Image size 2352x1568:
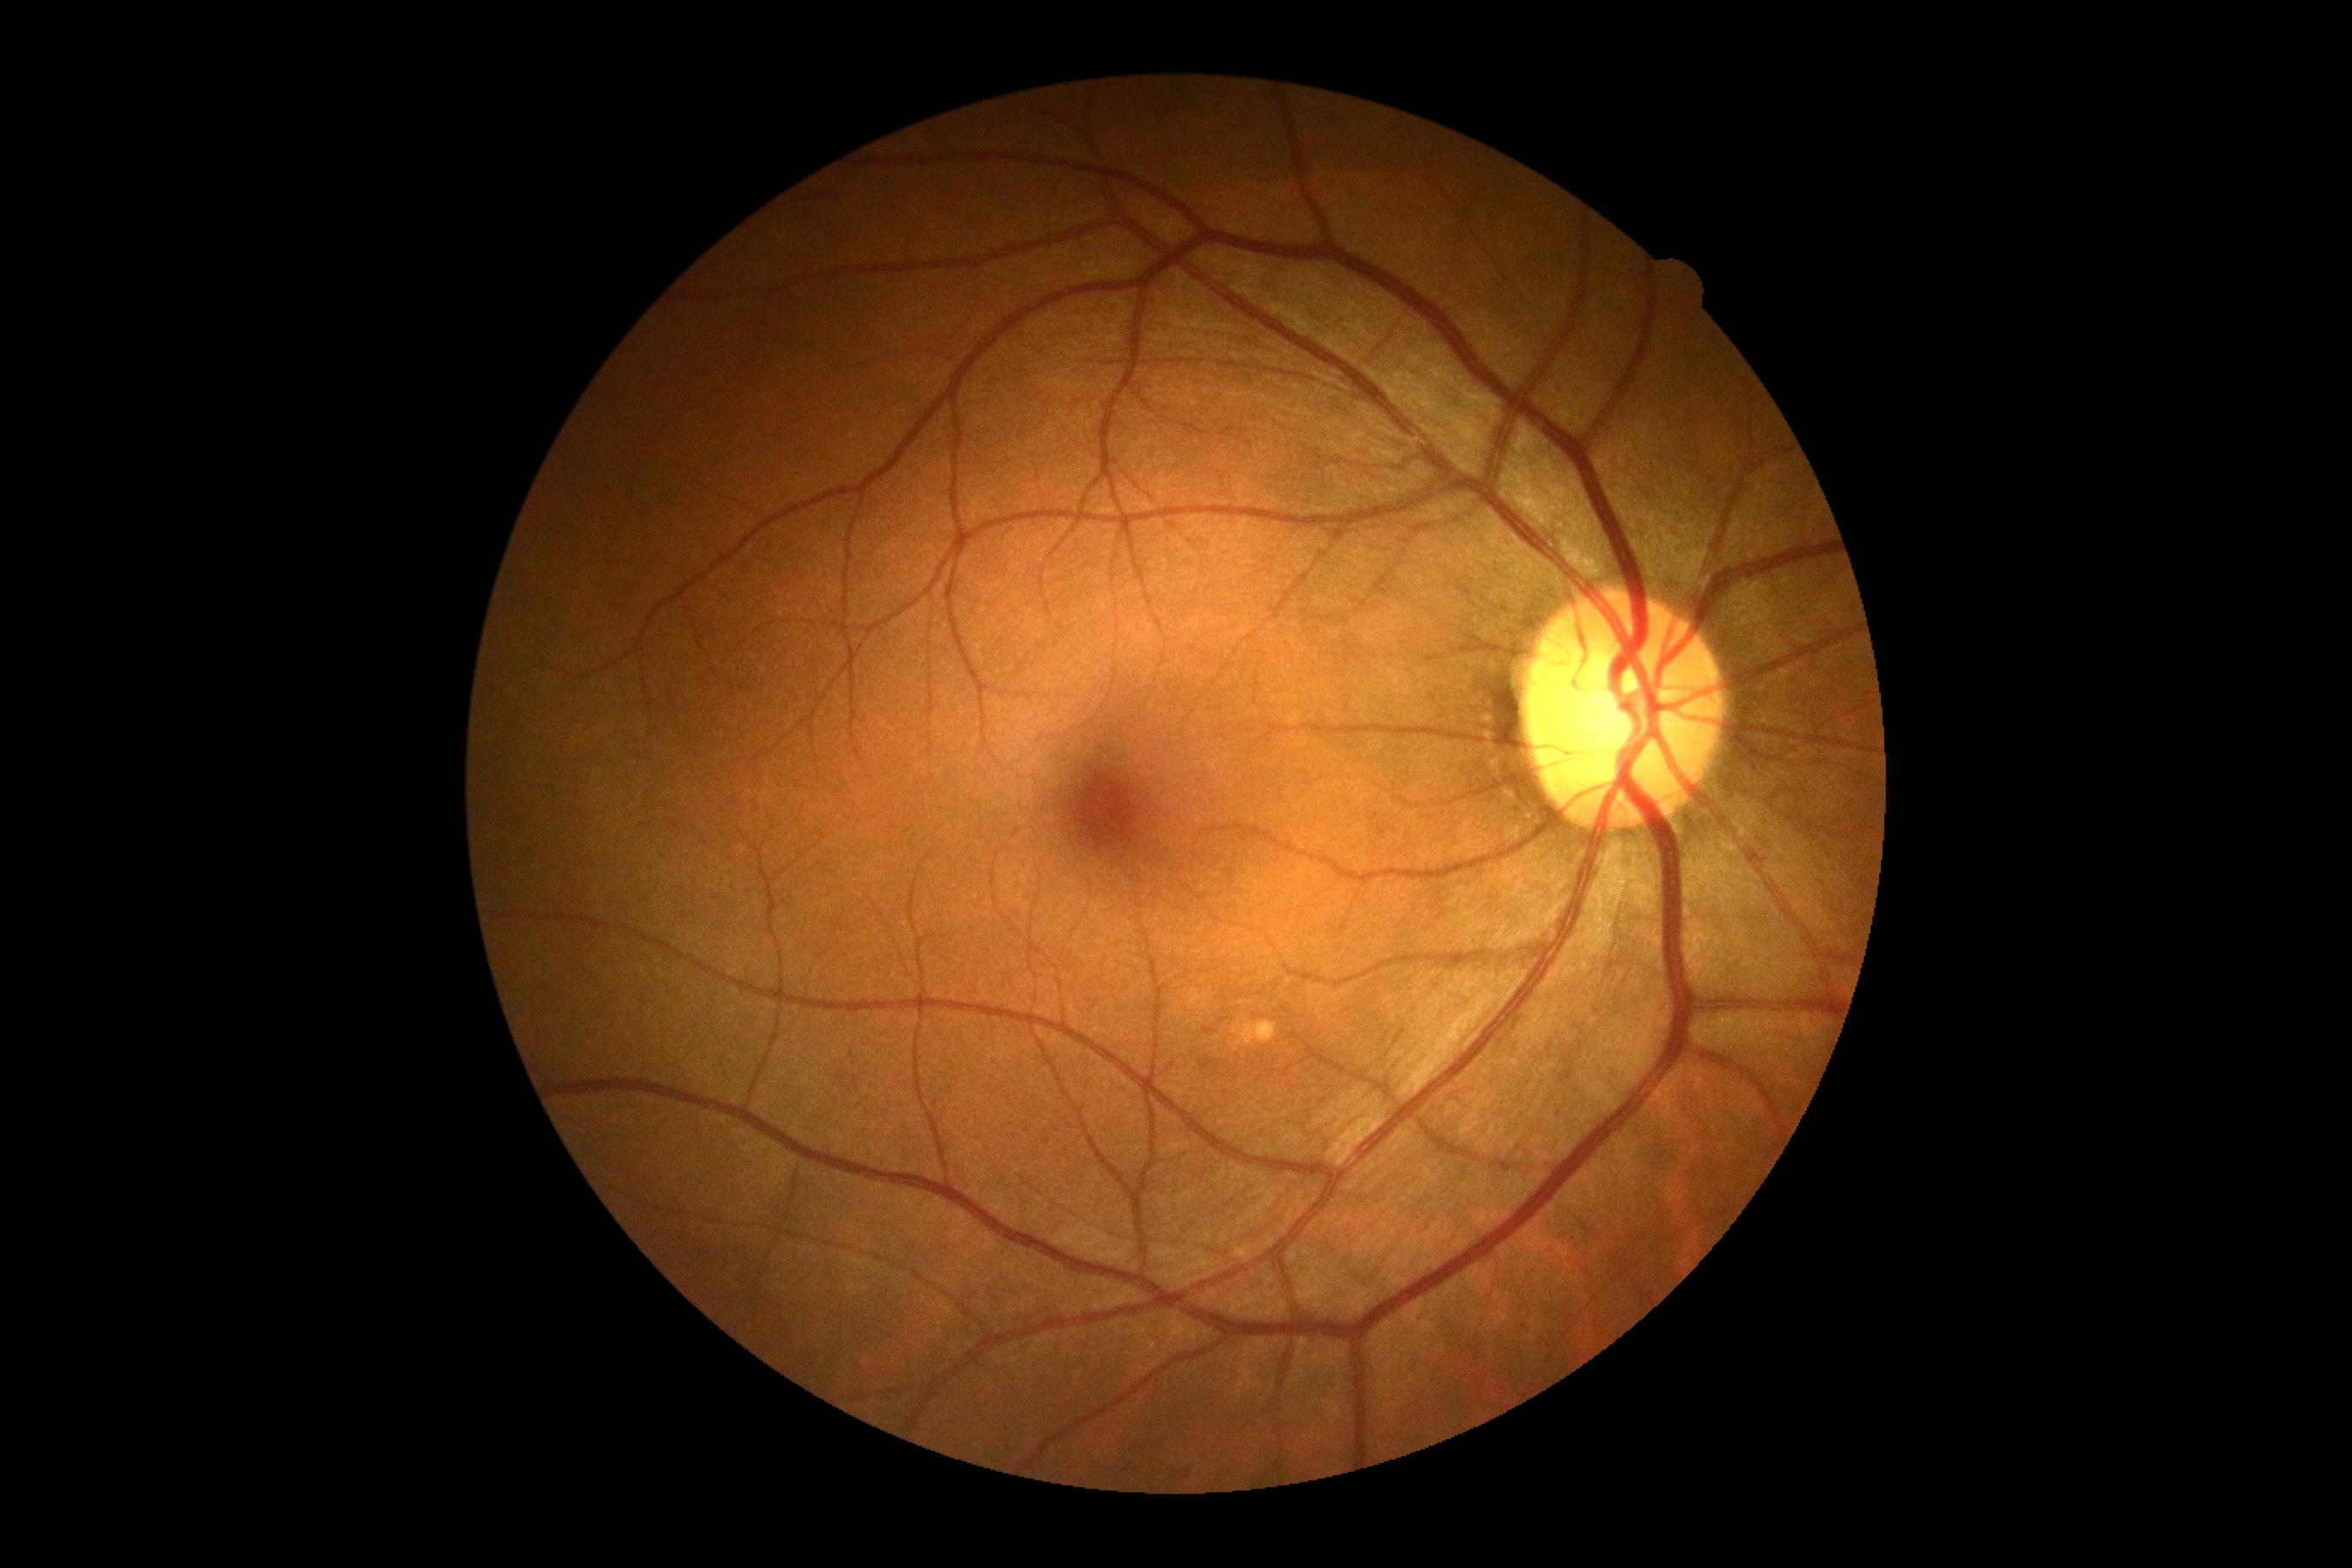

DR severity is no apparent diabetic retinopathy (grade 0).